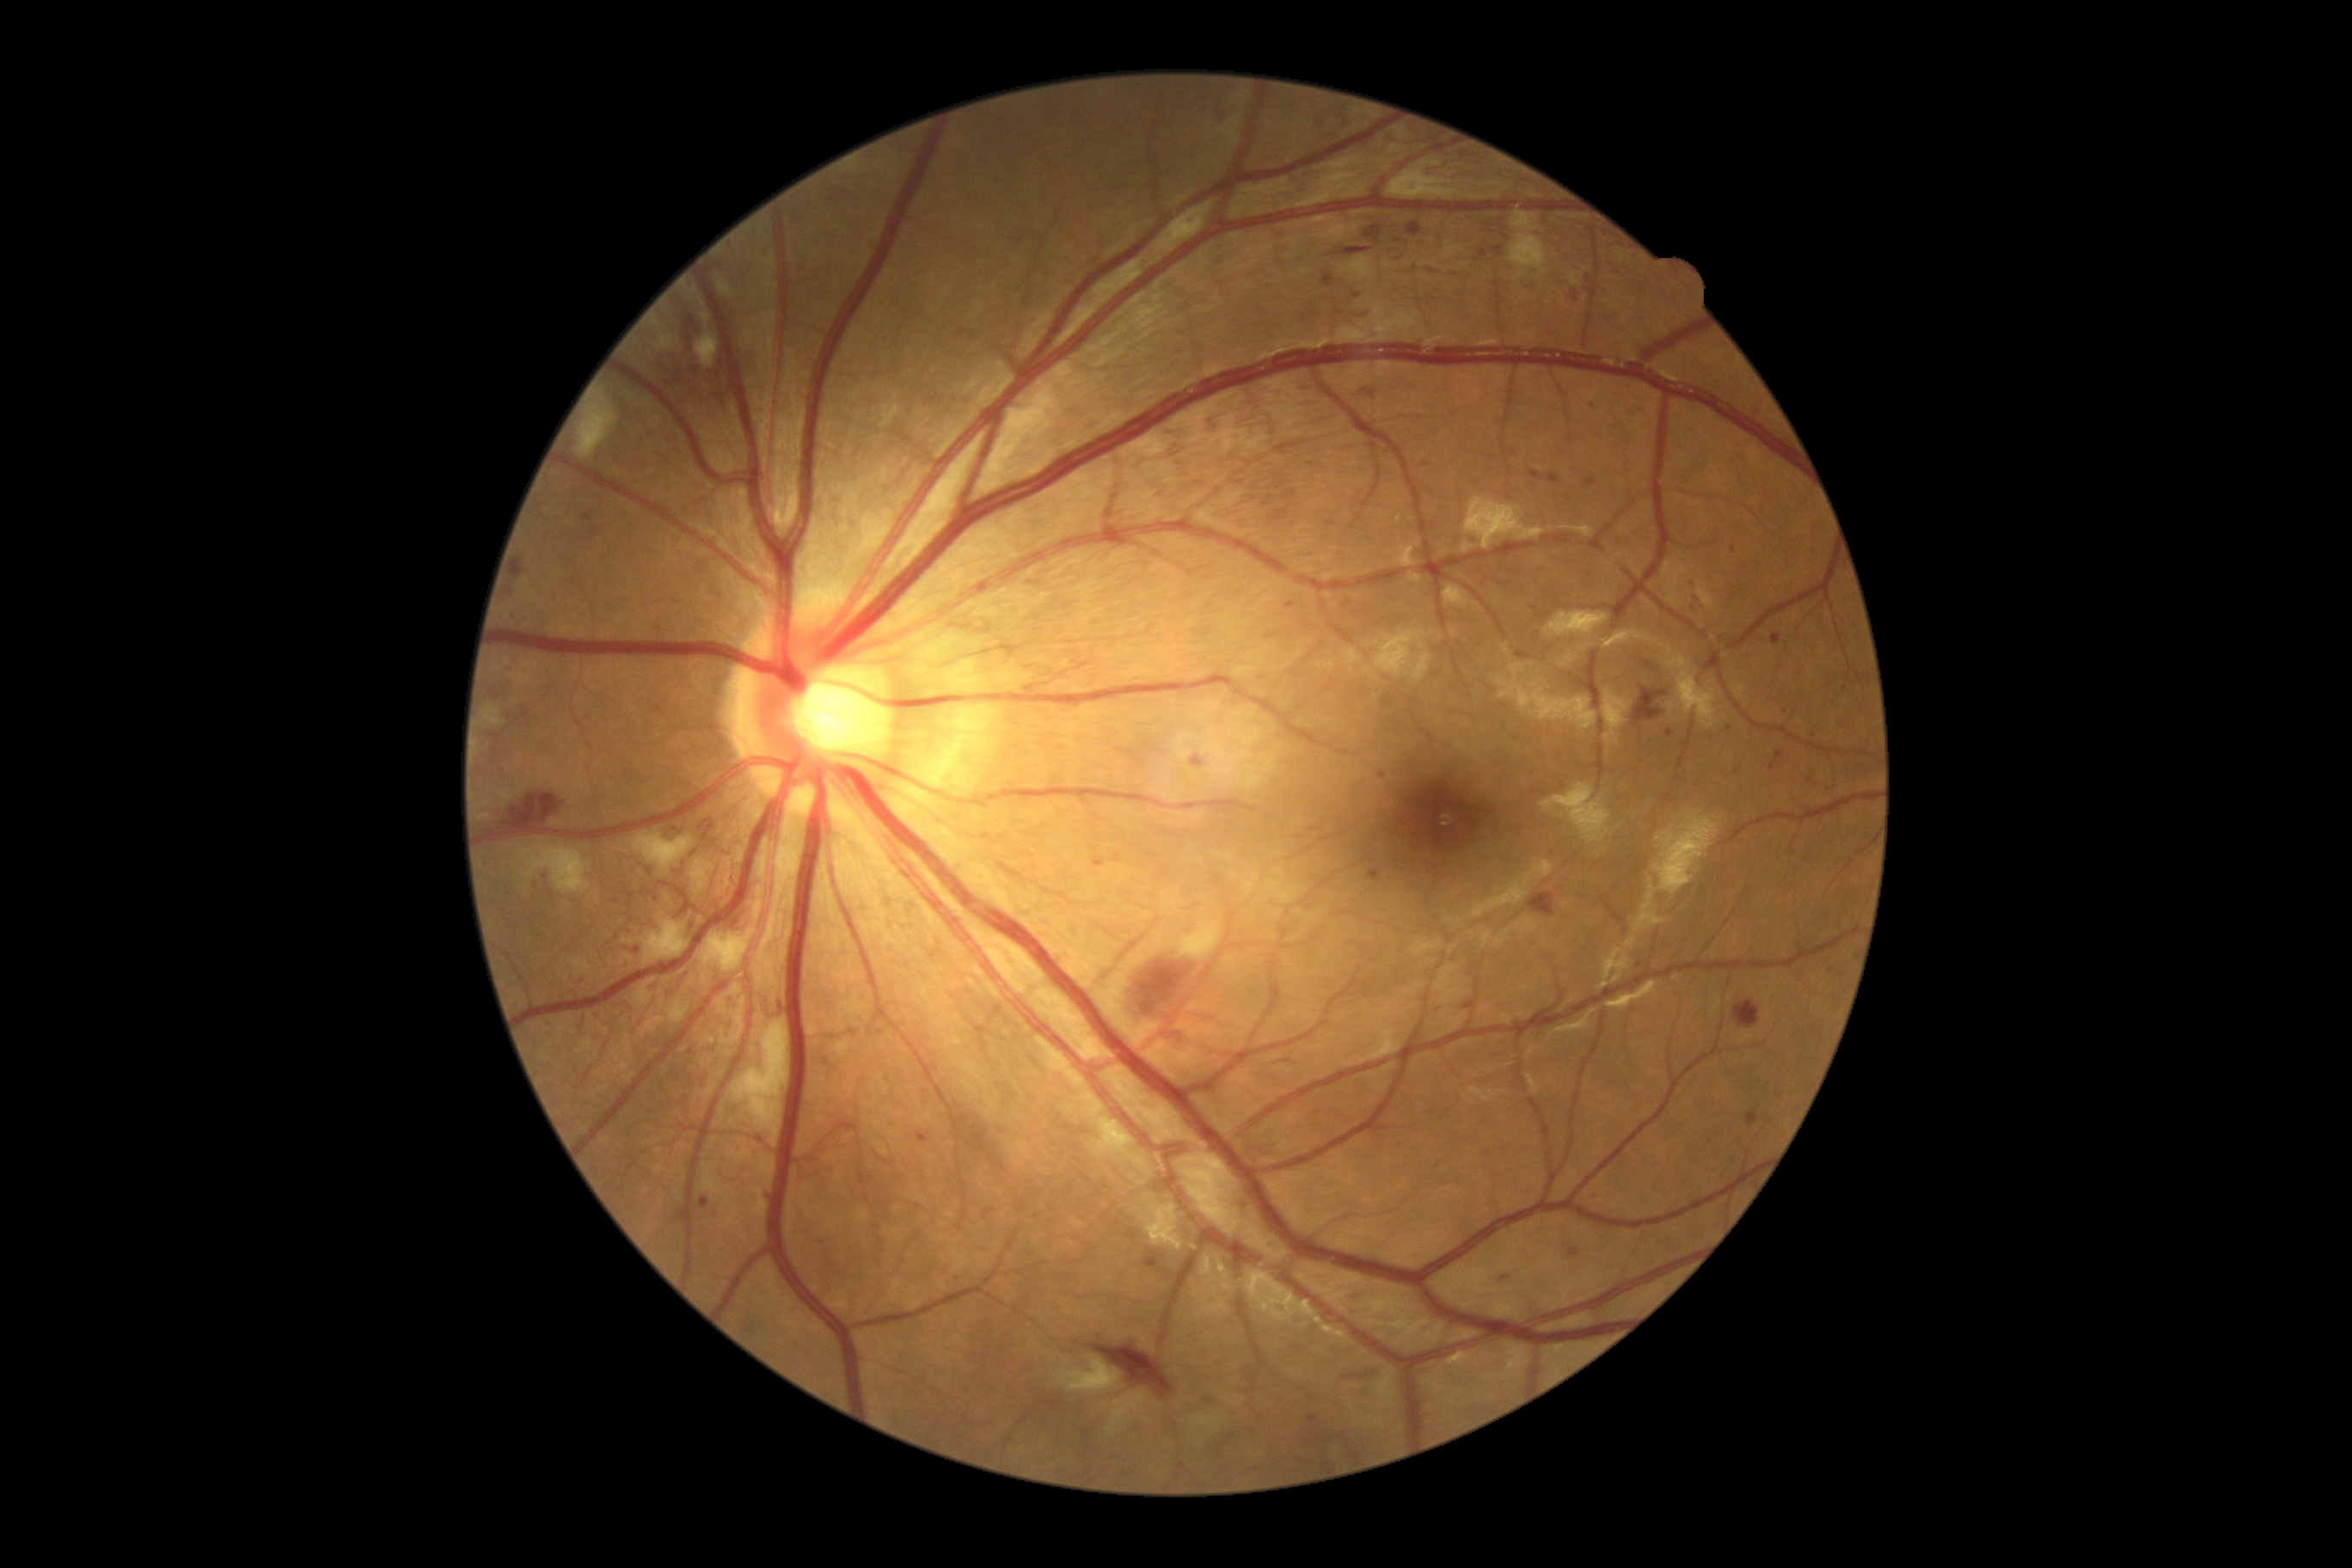

Diabetic retinopathy (DR): grade 3 (severe NPDR)
Representative lesions:
- microaneurysms (MAs): absent
- soft exudates (SEs) (continued): left=695, top=331, right=720, bottom=369 | left=640, top=917, right=689, bottom=965 | left=701, top=312, right=711, bottom=324 | left=1155, top=202, right=1215, bottom=260 | left=575, top=391, right=616, bottom=460 | left=634, top=833, right=695, bottom=874 | left=732, top=1022, right=788, bottom=1146 | left=1509, top=236, right=1548, bottom=278 | left=654, top=334, right=675, bottom=352 | left=718, top=996, right=728, bottom=1017 | left=1512, top=212, right=1538, bottom=231
- hard exudates (EXs): absent
- hemorrhages (HEs) (continued): left=1624, top=403, right=1646, bottom=420 | left=1686, top=577, right=1708, bottom=613 | left=1569, top=1247, right=1579, bottom=1259 | left=1273, top=510, right=1289, bottom=522 | left=639, top=544, right=652, bottom=560 | left=1777, top=752, right=1785, bottom=761 | left=644, top=893, right=652, bottom=897 | left=1502, top=233, right=1514, bottom=245 | left=1381, top=699, right=1392, bottom=707 | left=1495, top=1275, right=1512, bottom=1287 | left=1191, top=756, right=1204, bottom=768 | left=1486, top=228, right=1497, bottom=238 | left=1462, top=1003, right=1476, bottom=1010 | left=647, top=297, right=752, bottom=424 | left=666, top=824, right=683, bottom=840
- Additional small HEs near [753,233] | [958,1280] | [1377,239] | [503,912]